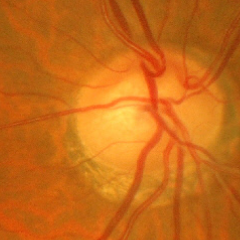
Fundus image with findings of no glaucoma.